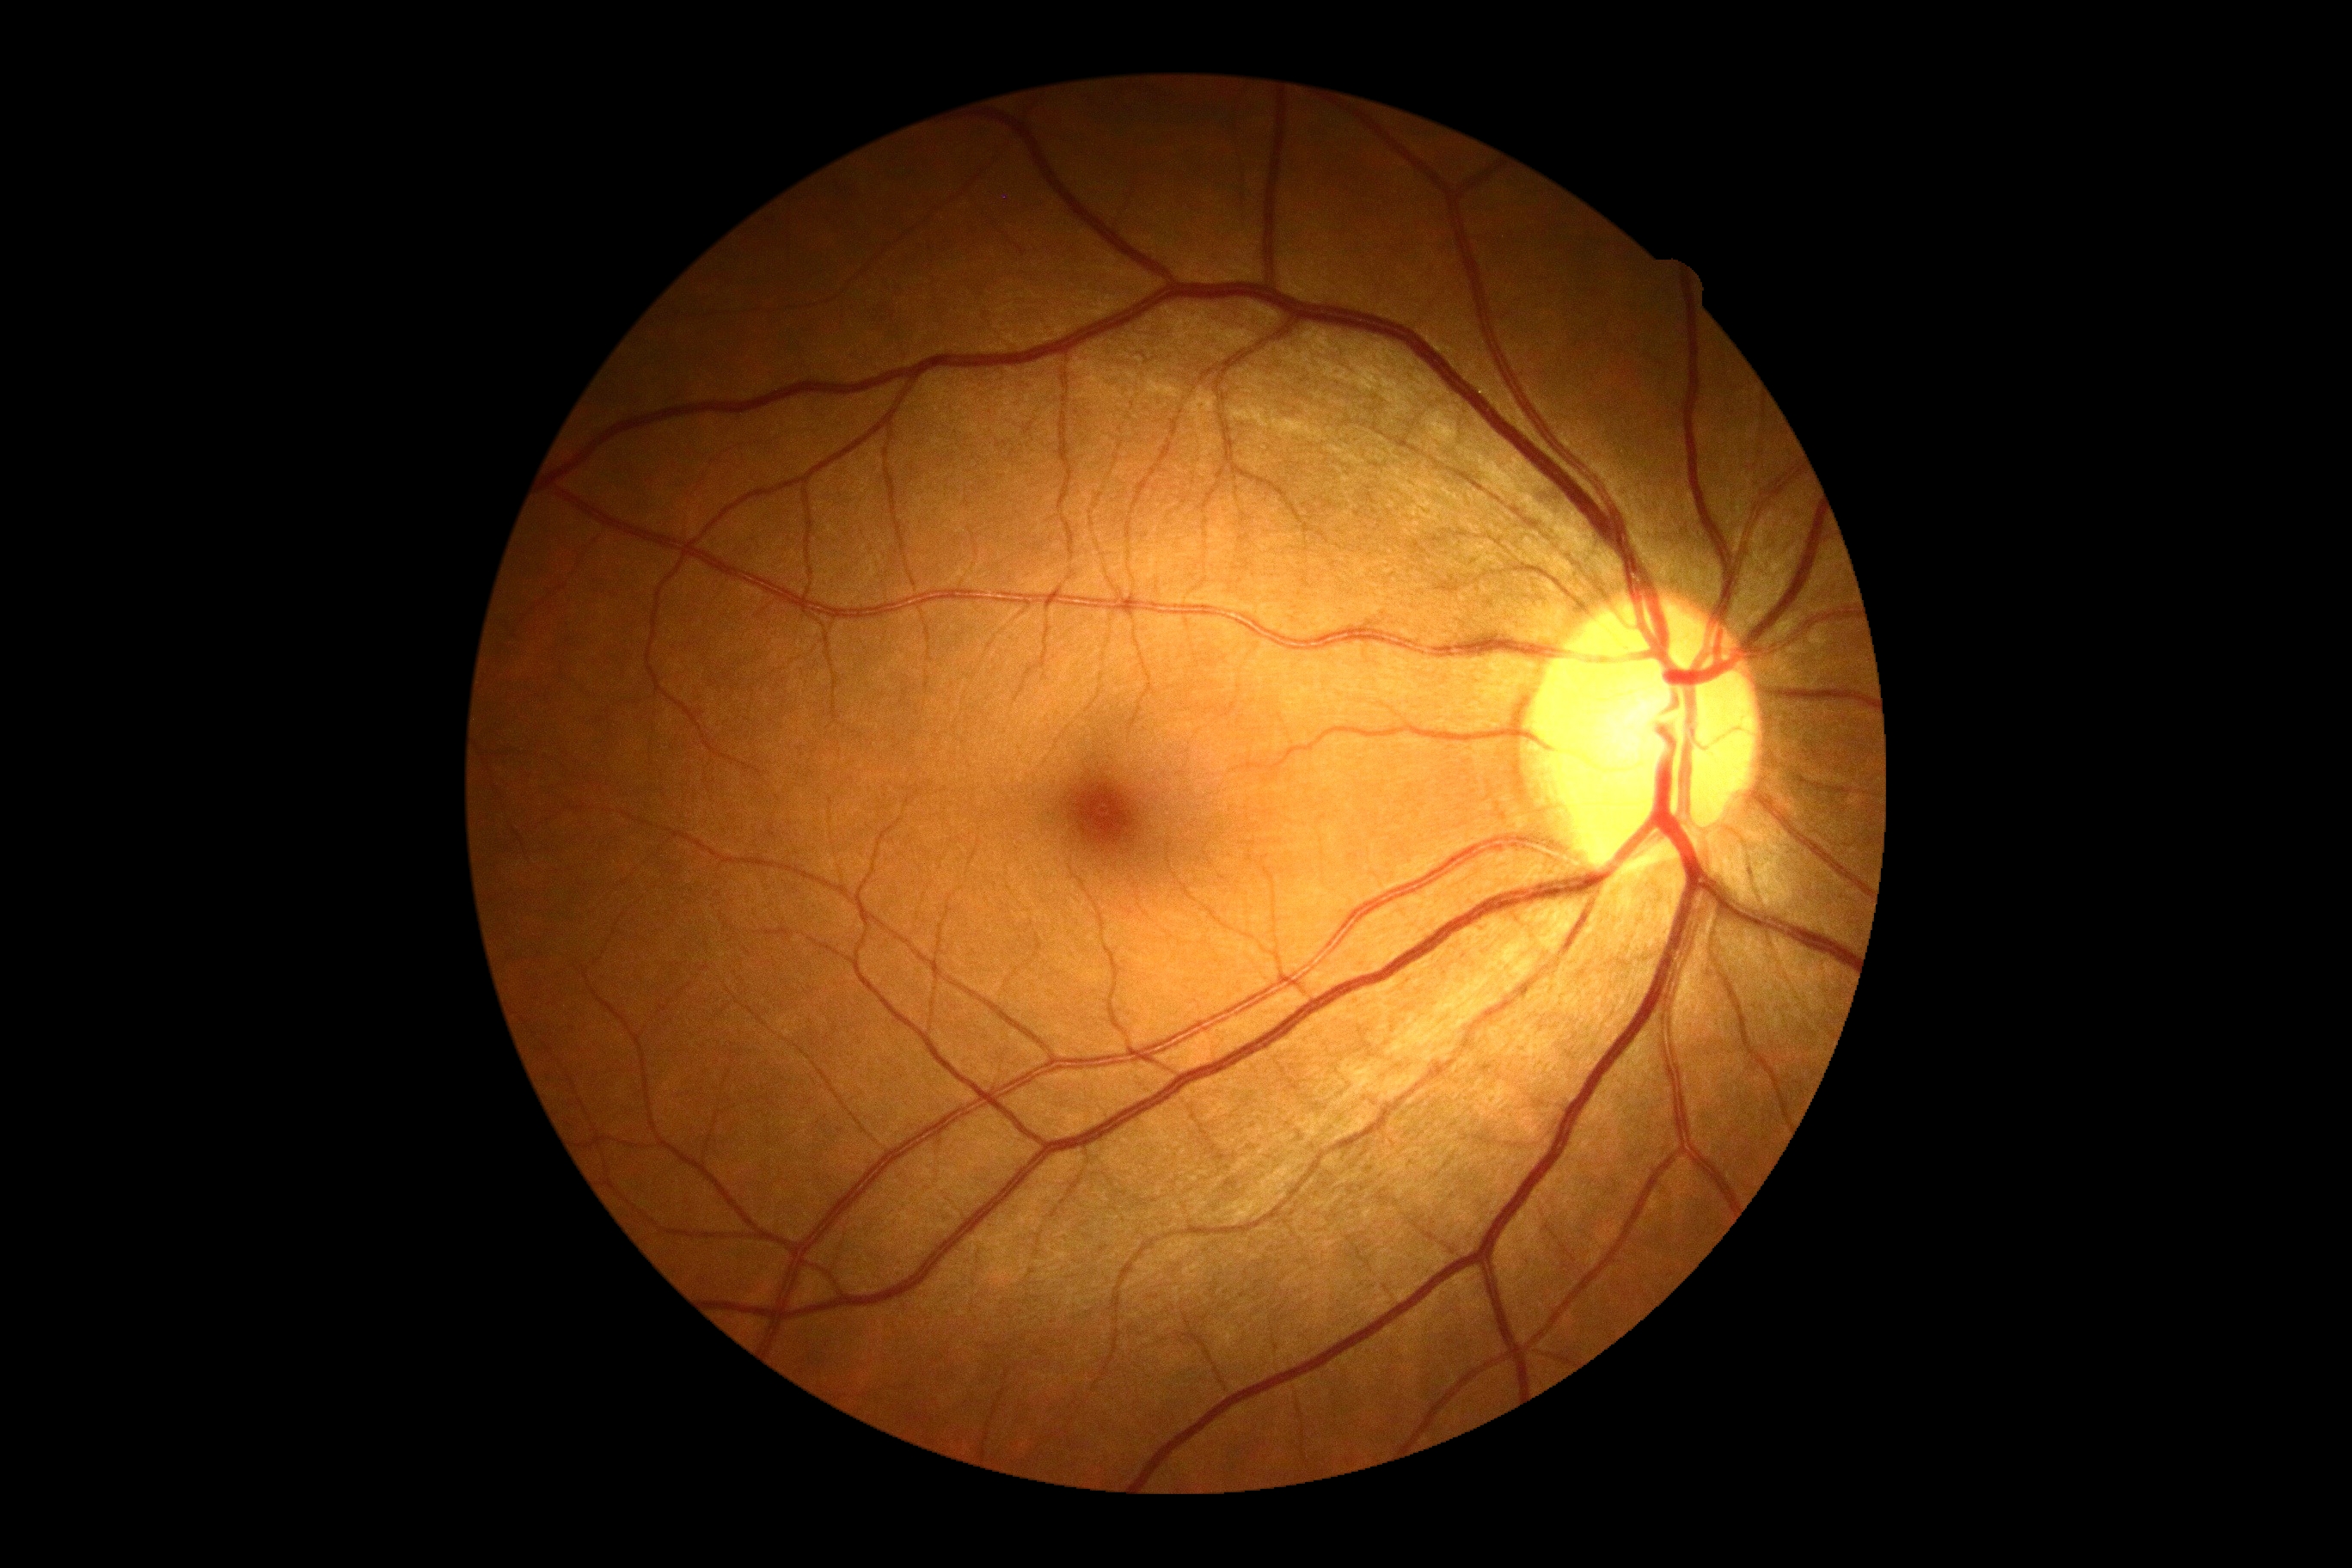
DR: grade 0 (no apparent retinopathy).
No apparent diabetic retinopathy.